Natus RetCam Envision, 130° FOV. Infant wide-field fundus photograph:
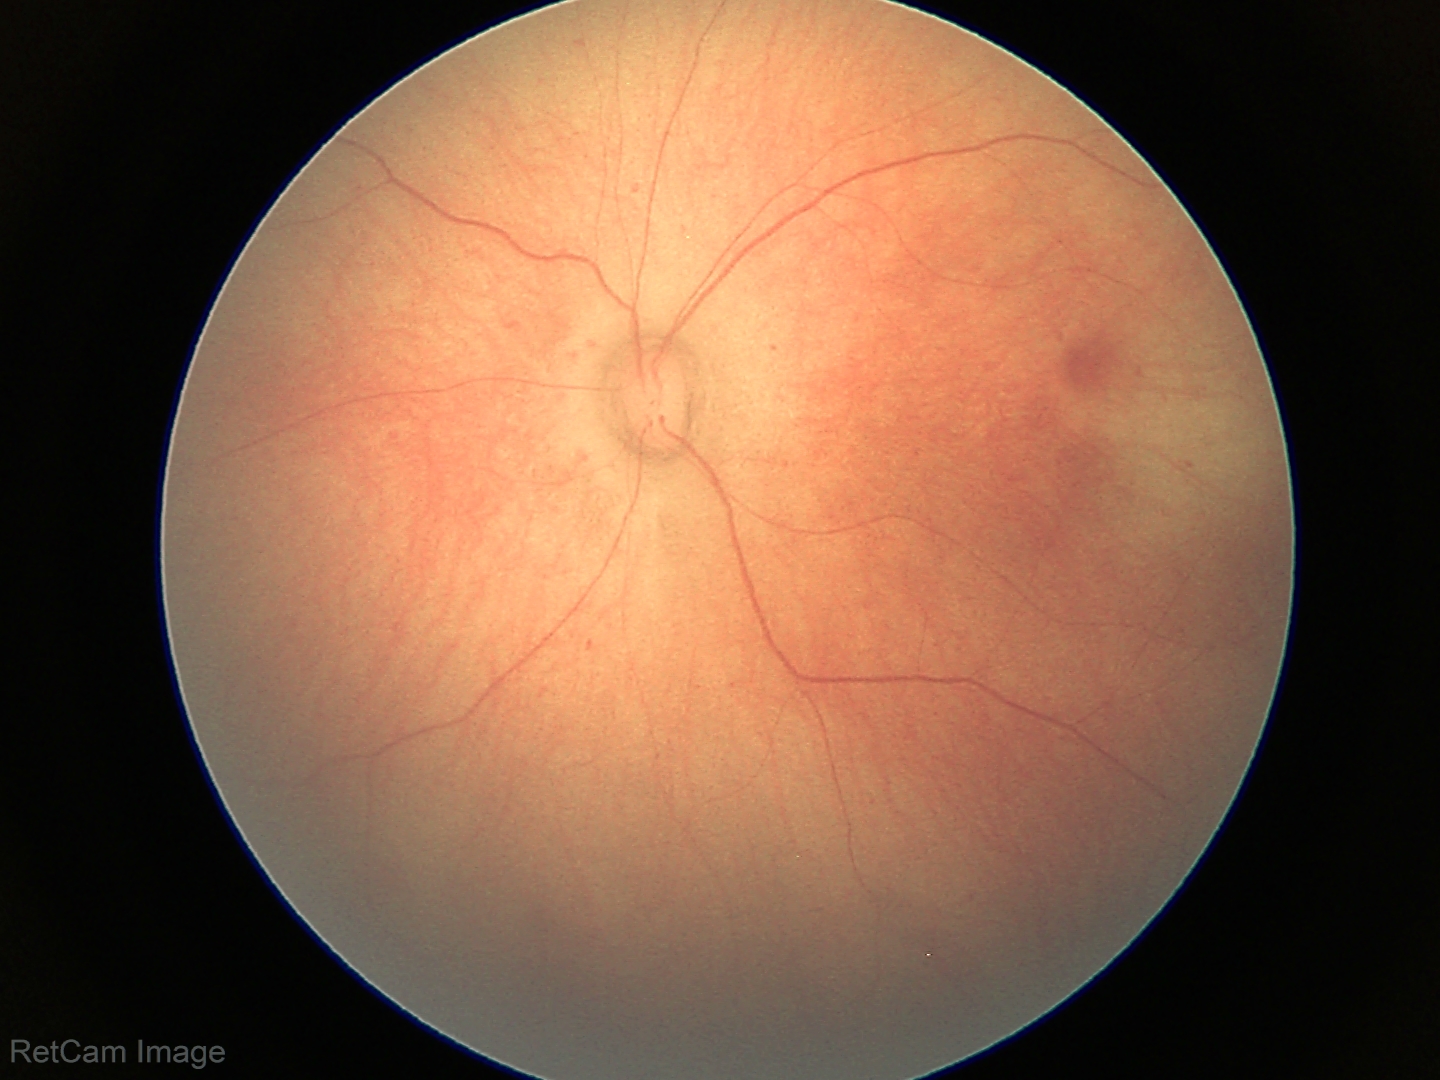

Screening diagnosis = no abnormalities.